45° field of view: 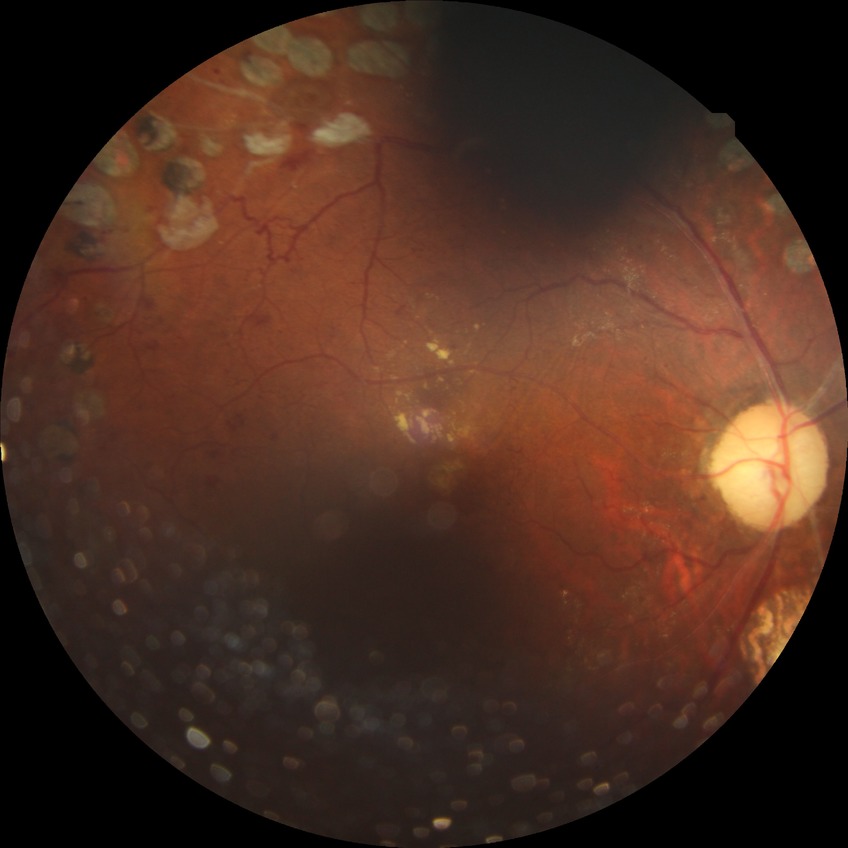

Diabetic retinopathy (DR) is proliferative diabetic retinopathy (PDR).